45° field of view. 2352 by 1568 pixels — 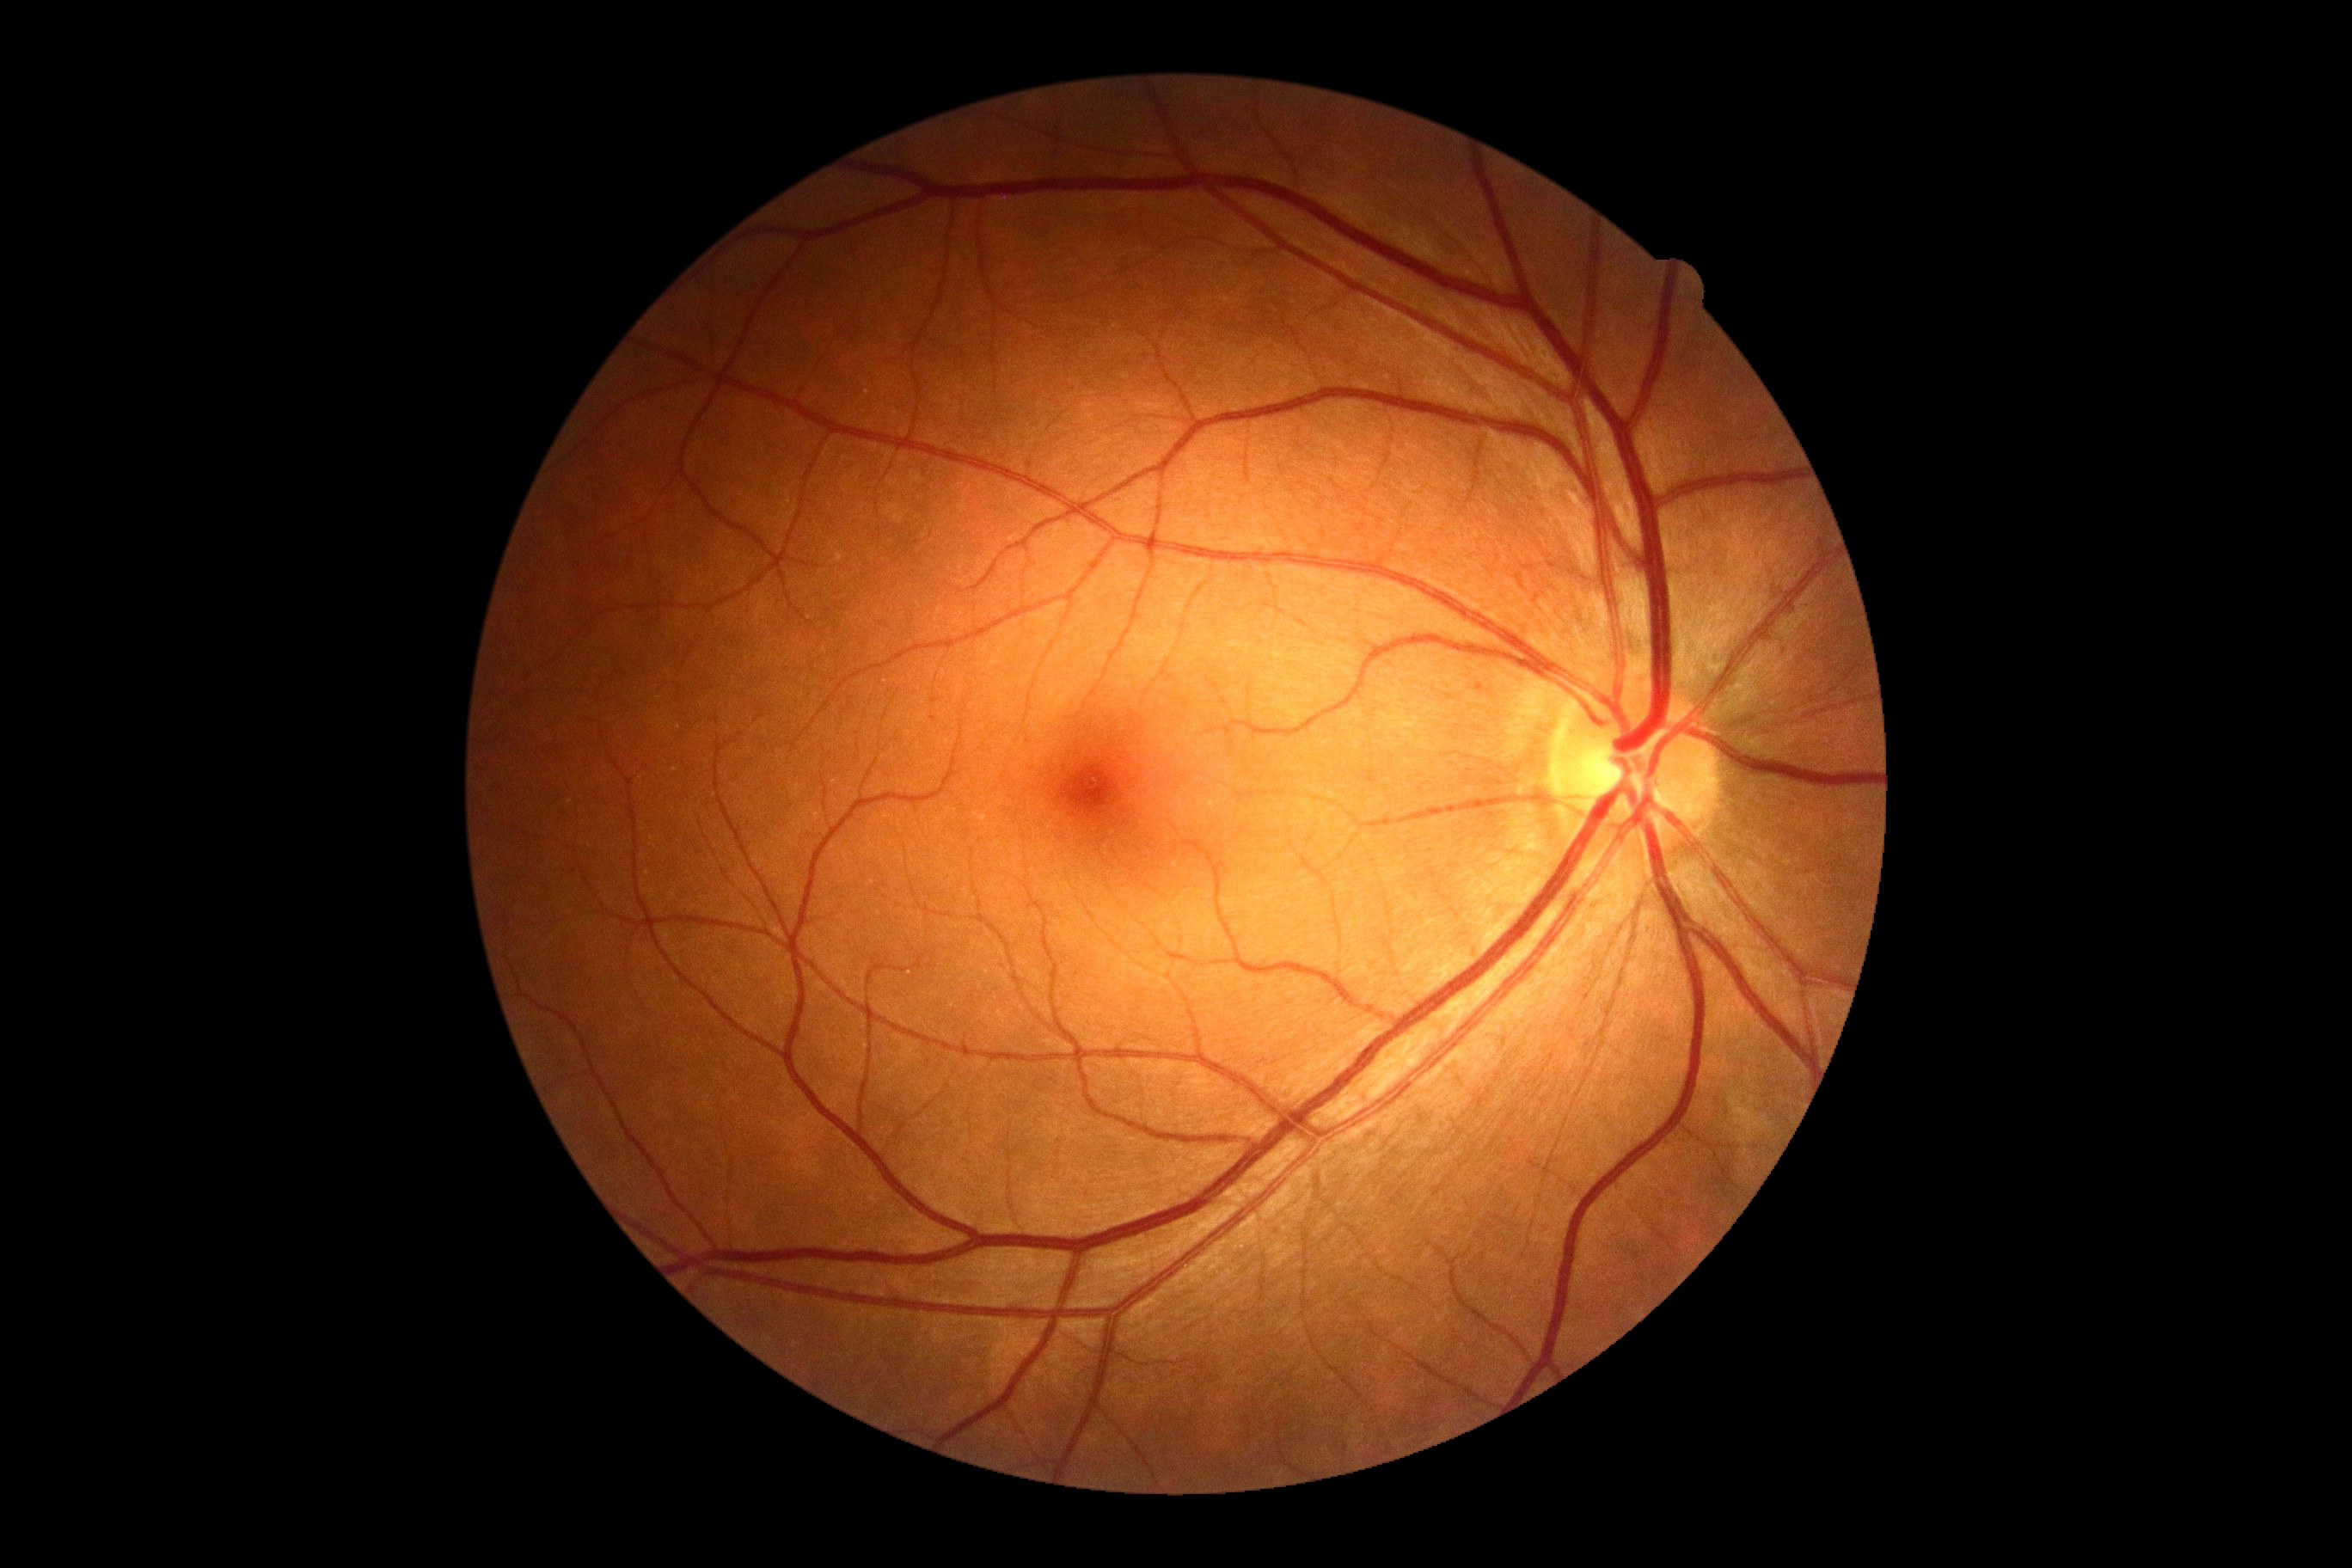 Annotations:
- diabetic retinopathy (DR): no apparent diabetic retinopathy (grade 0)
- DR impression: no signs of DR